130° field of view (Clarity RetCam 3). Infant wide-field retinal image
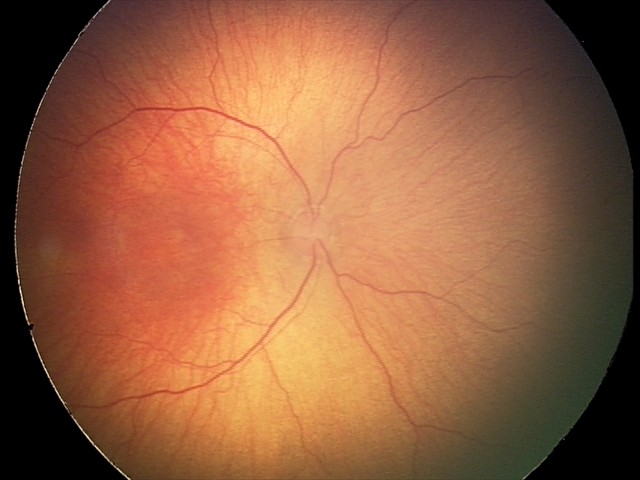

Plus disease absent. Examination diagnosed as status post ROP.